848x848px, diabetic retinopathy graded by the modified Davis classification, FOV: 45 degrees.
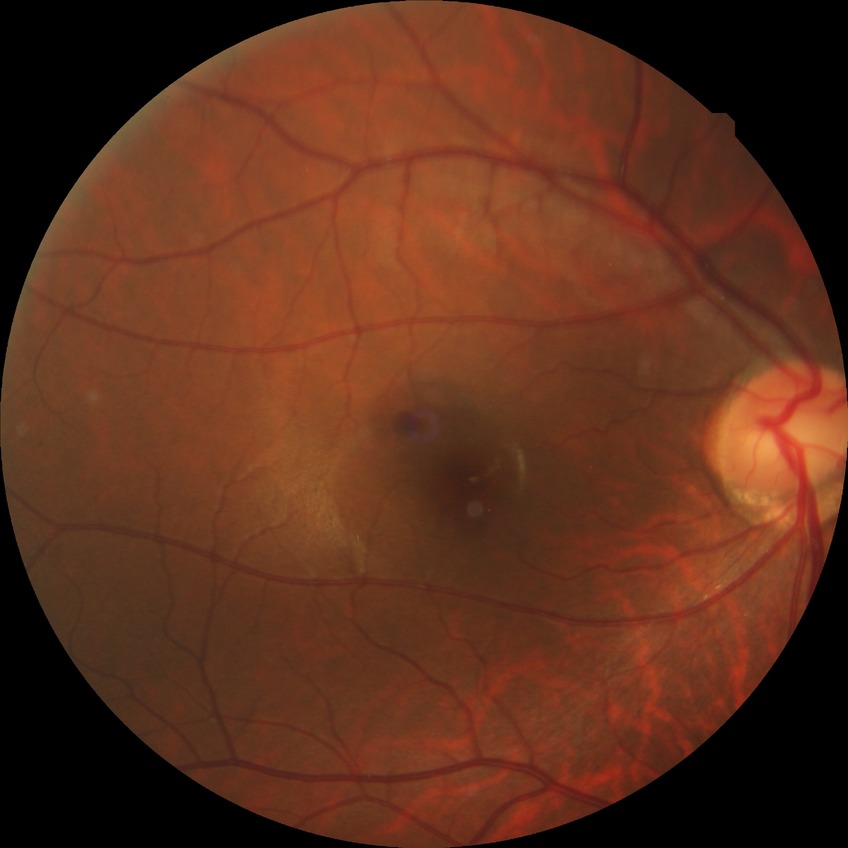
Modified Davis classification: no diabetic retinopathy.